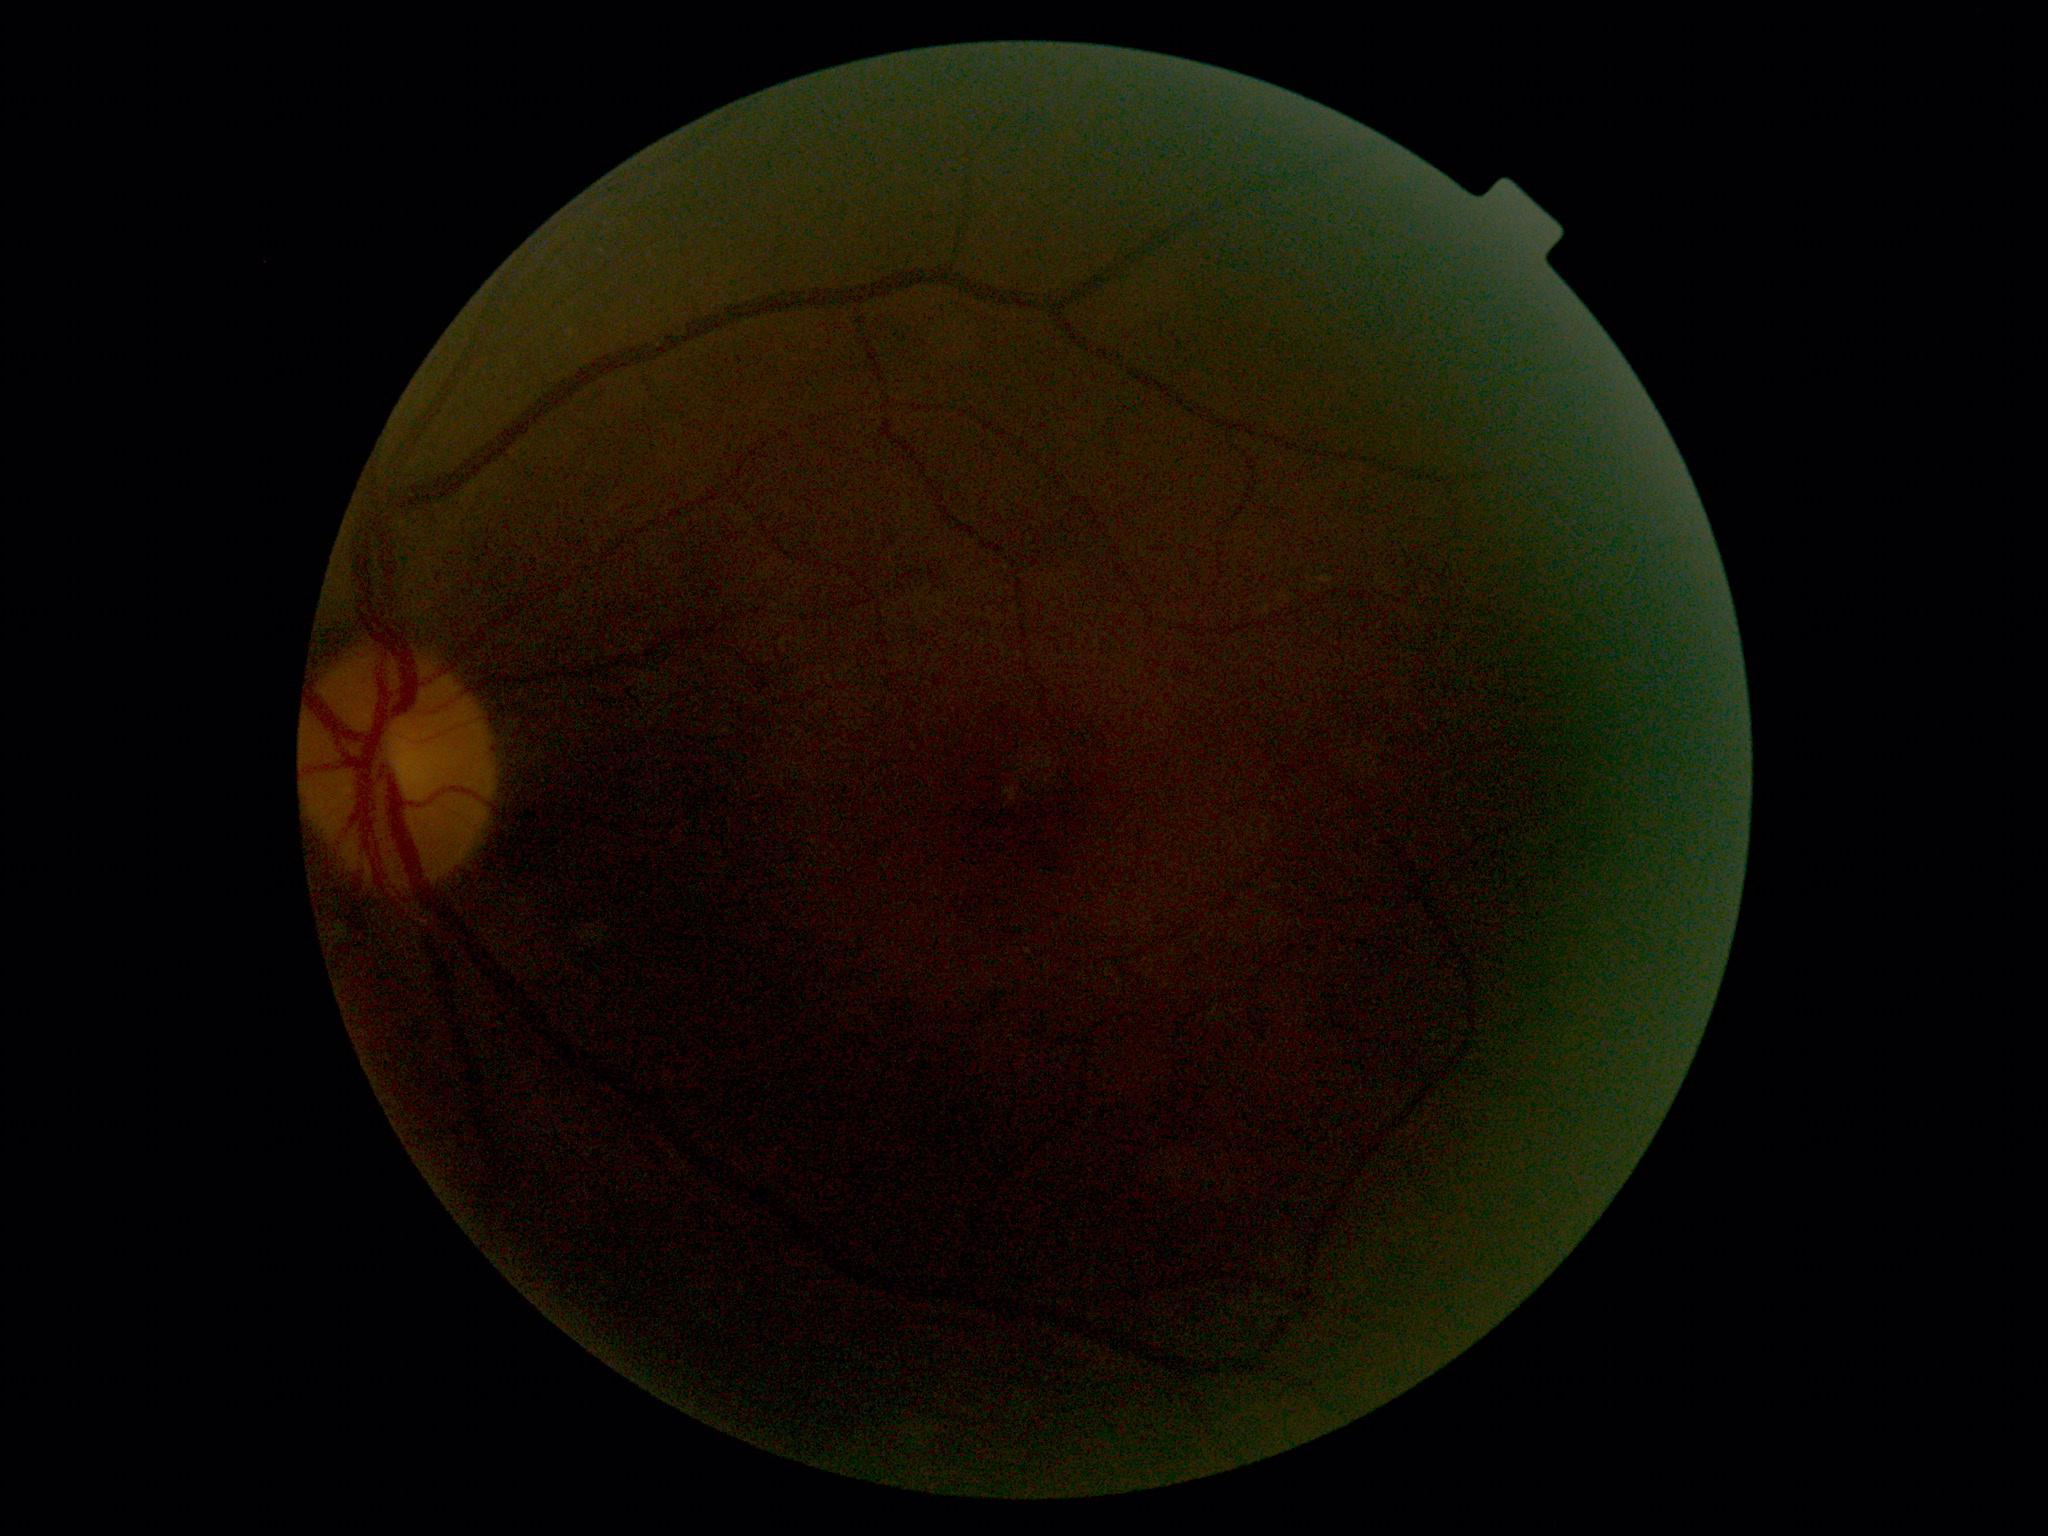 Diabetic retinopathy (DR): ungradable. Ungradable image — DR severity cannot be determined.